Fundus photo · 2212x1659: 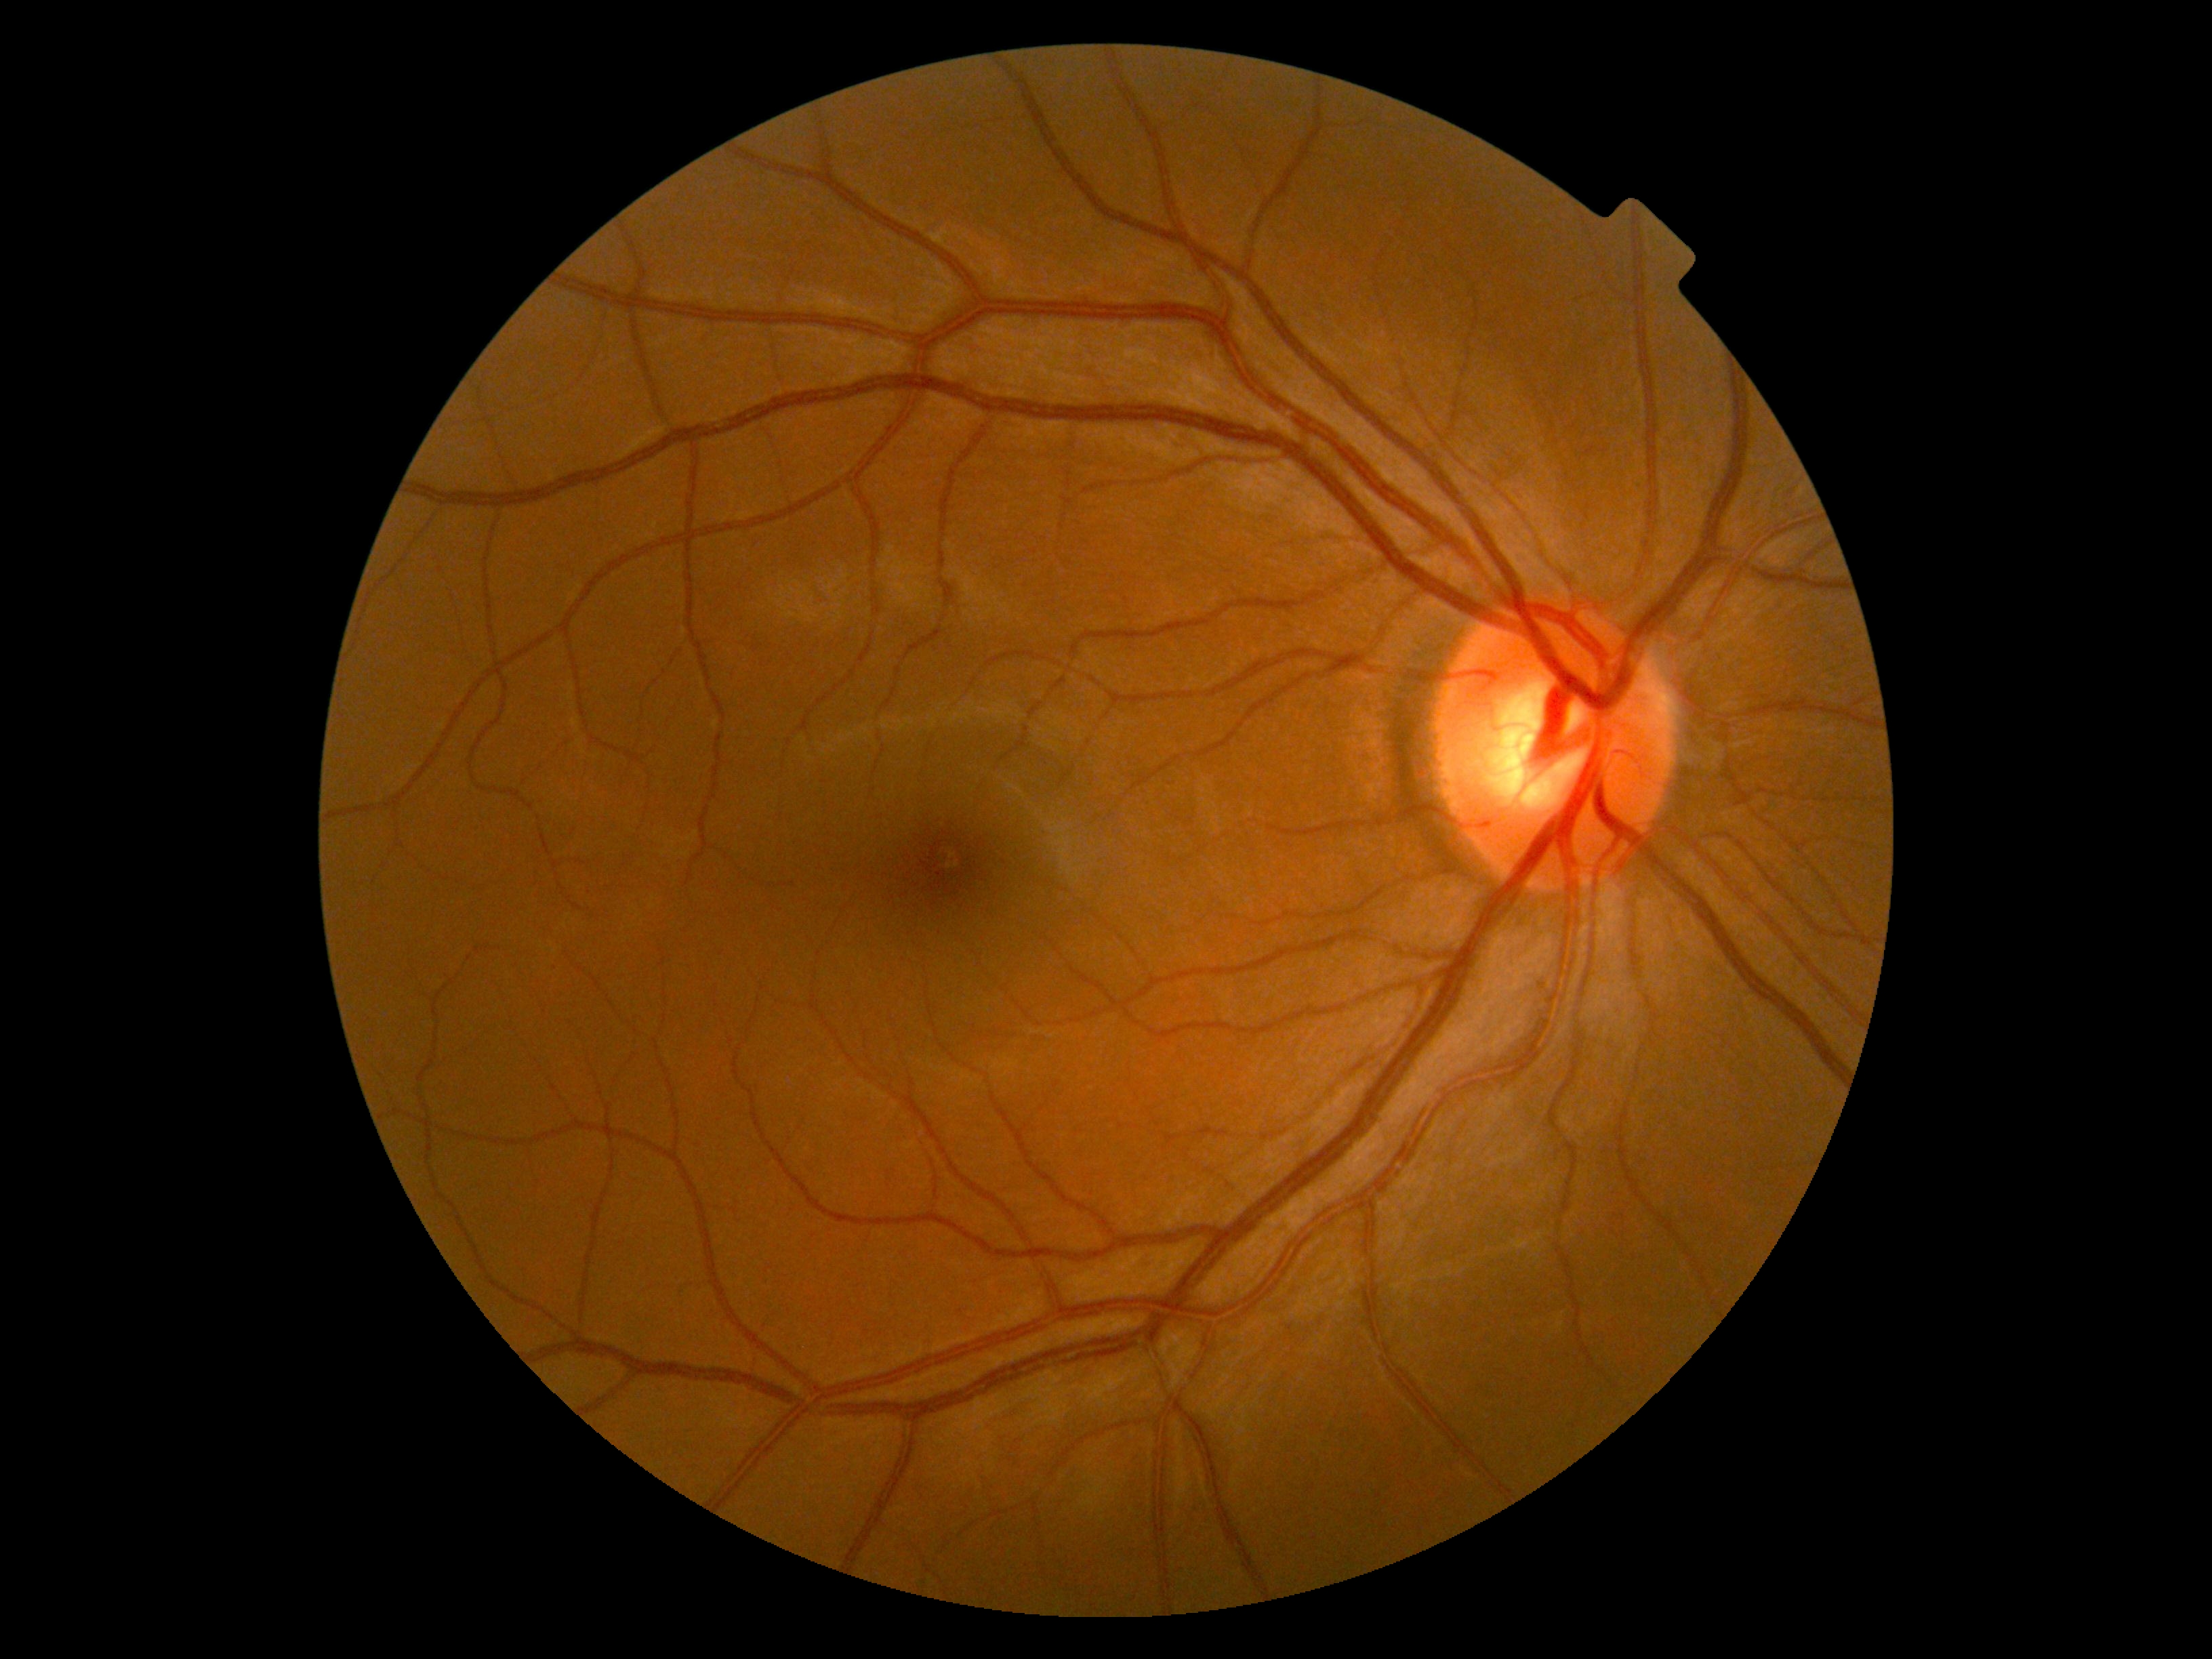

Retinopathy grade is 0.